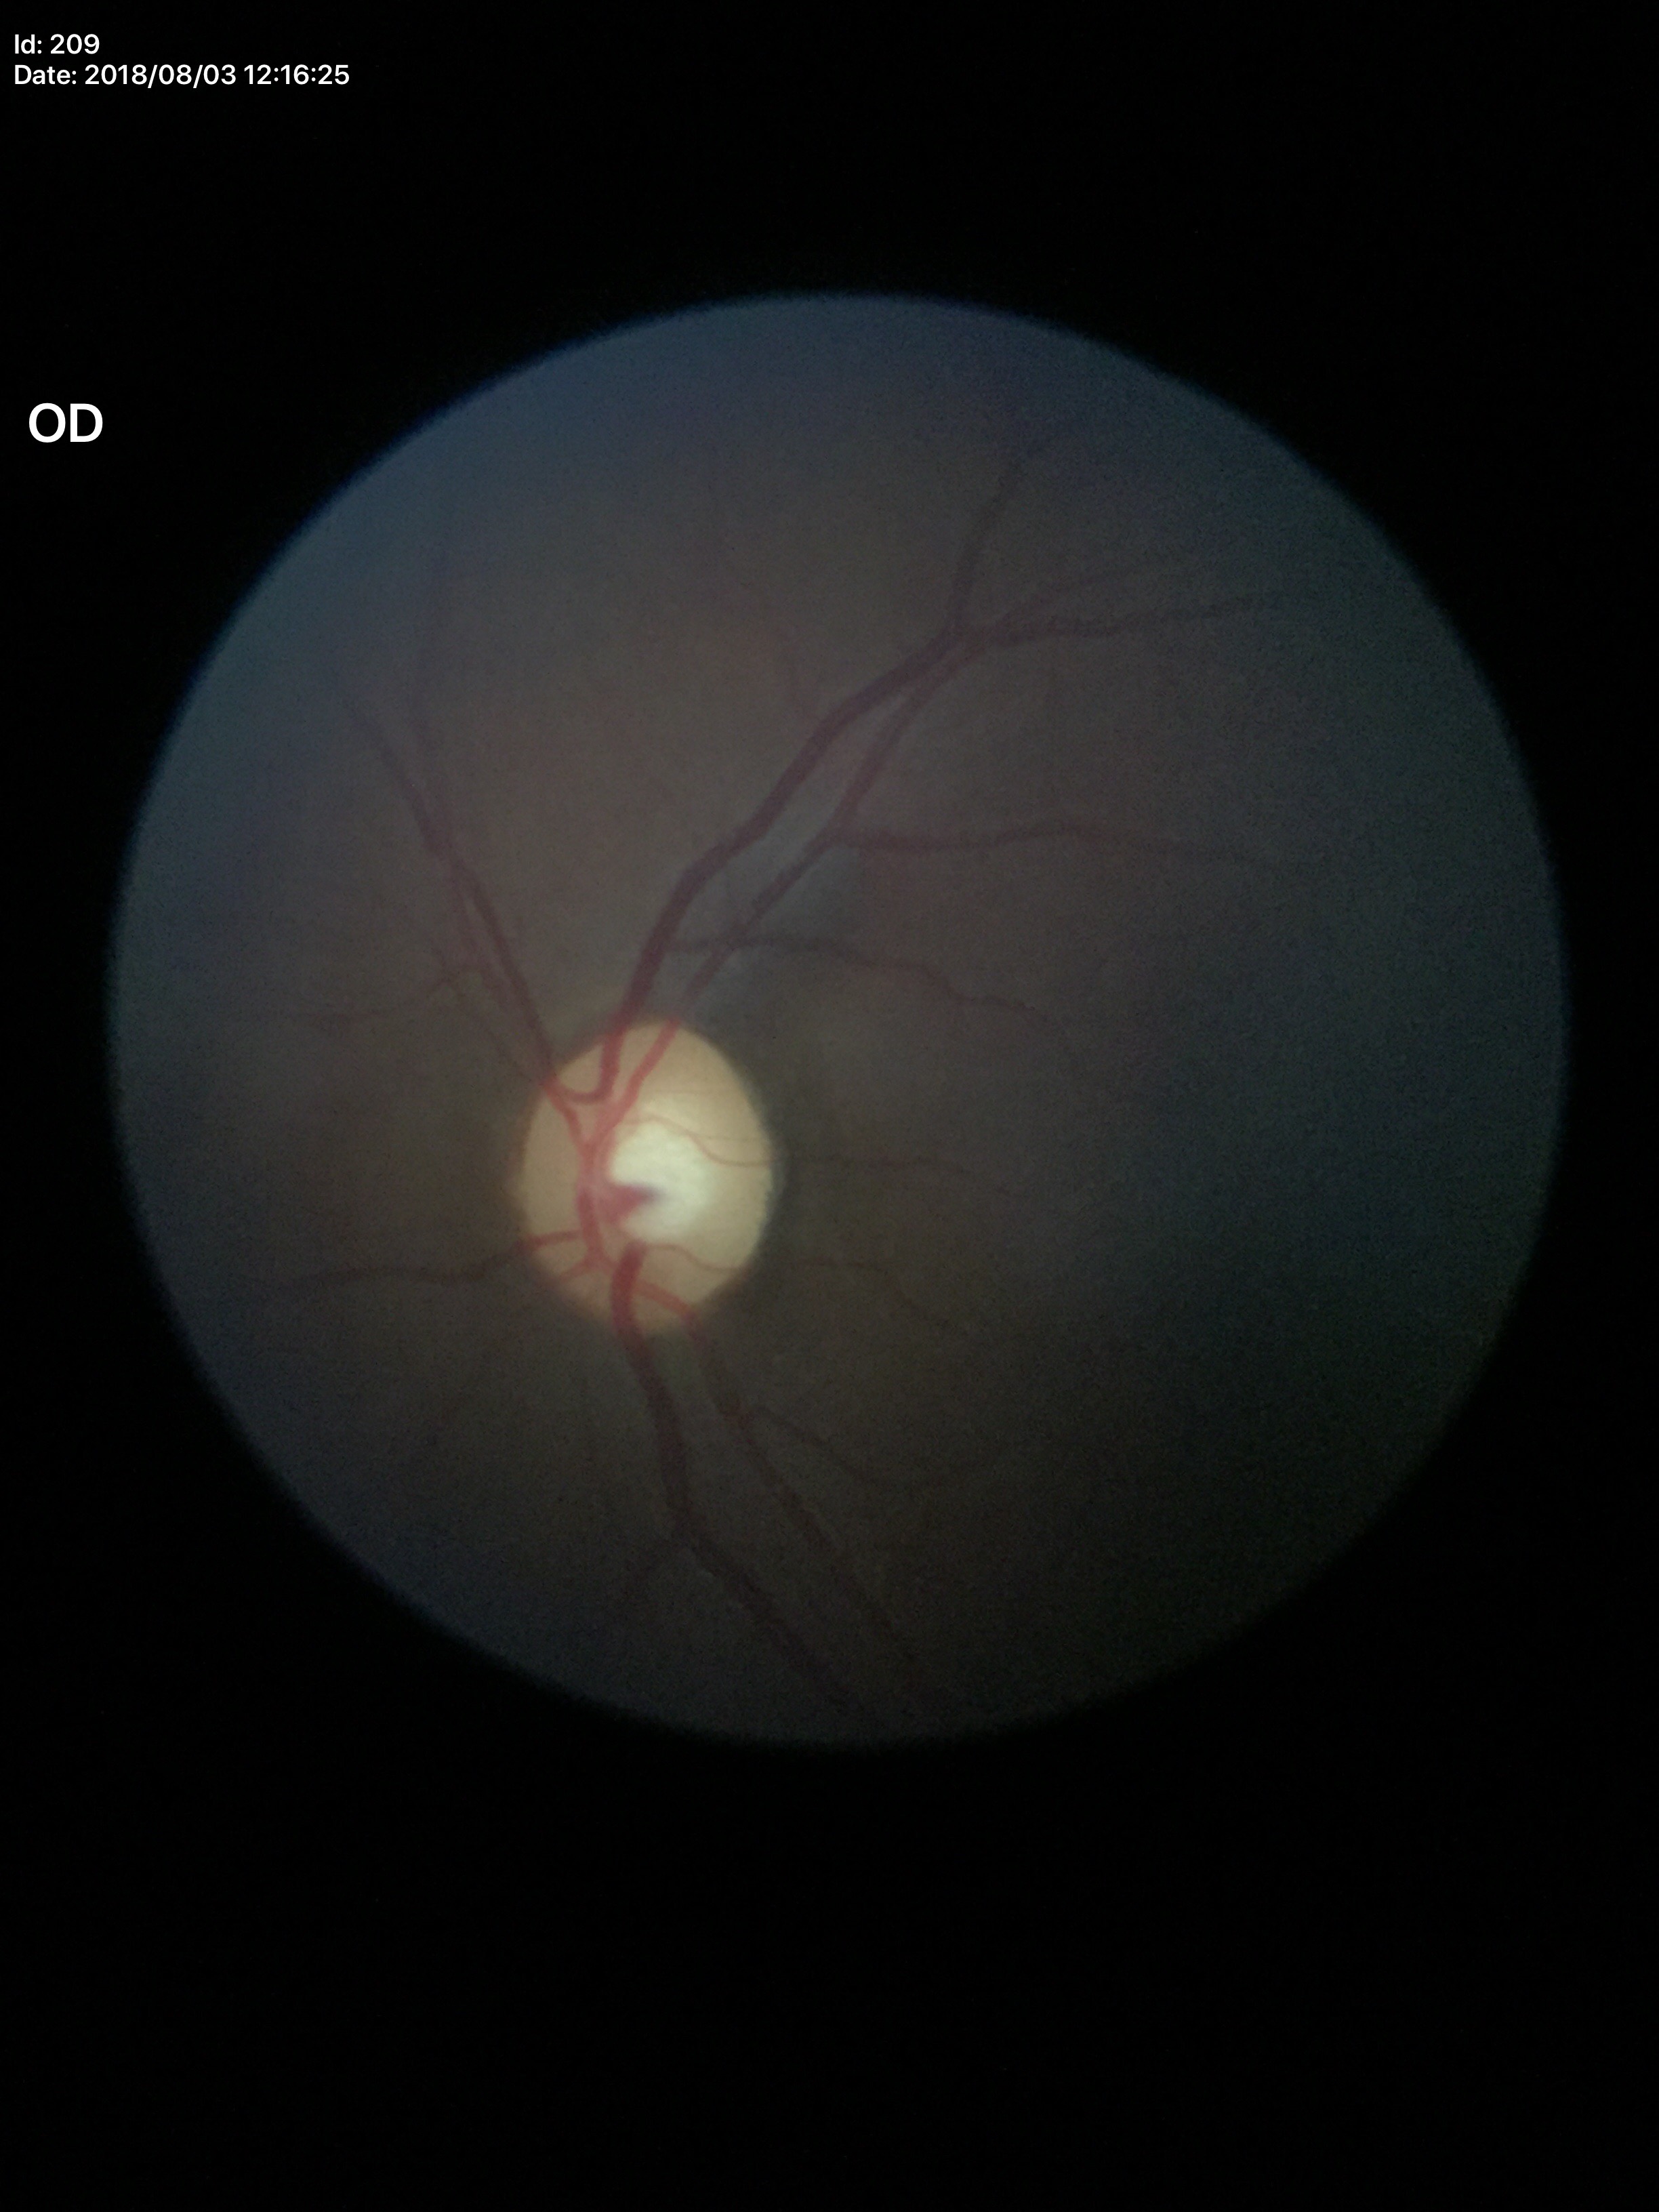 Horizontal C/D ratio: 0.53. Glaucoma assessment: no suspicious findings. Vertical cup-to-disc ratio is 0.53.